Retinal fundus photograph; 45 degree fundus photograph; no pharmacologic dilation; diabetic retinopathy graded by the modified Davis classification — 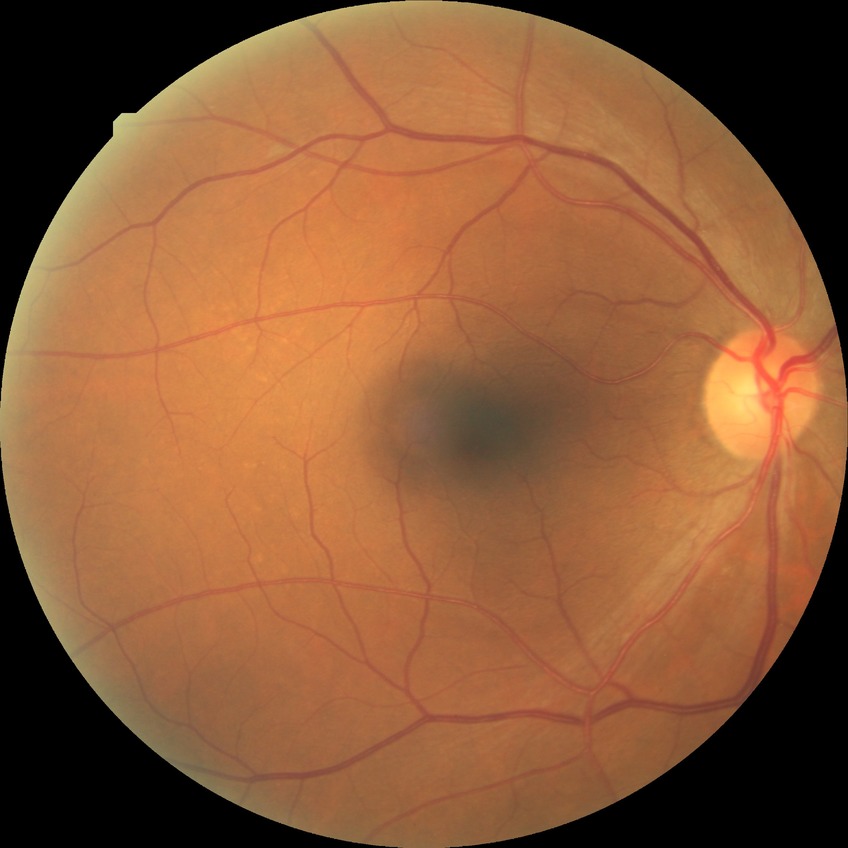
Modified Davis classification: no diabetic retinopathy.